NIDEK AFC-230 fundus camera. Color fundus photograph
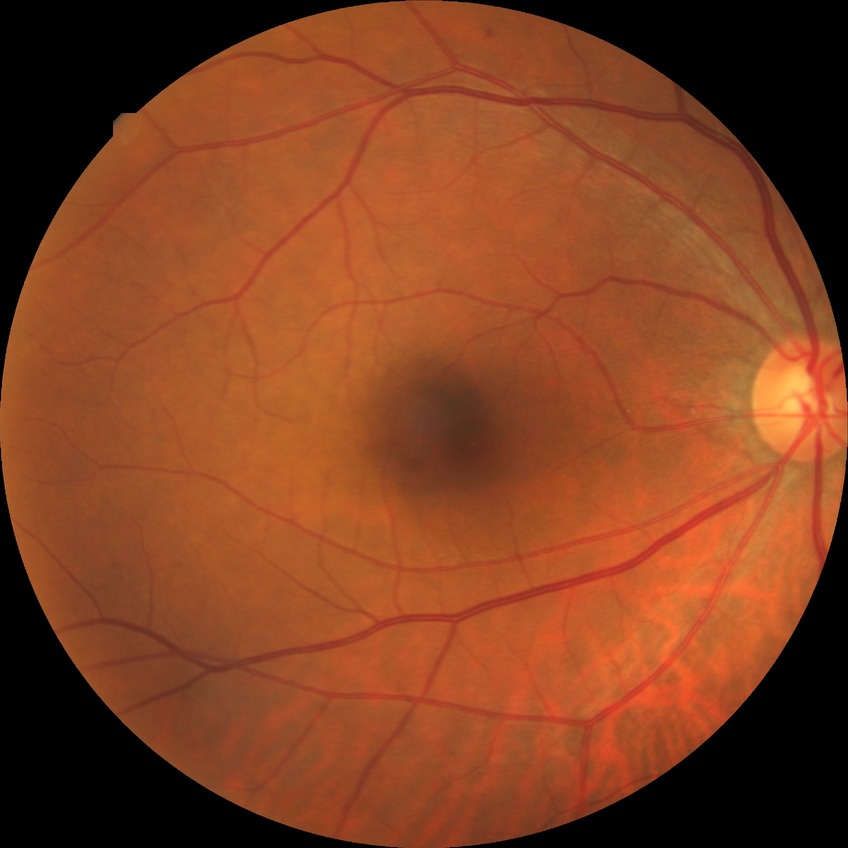
Diabetic retinopathy (DR): no diabetic retinopathy (NDR).